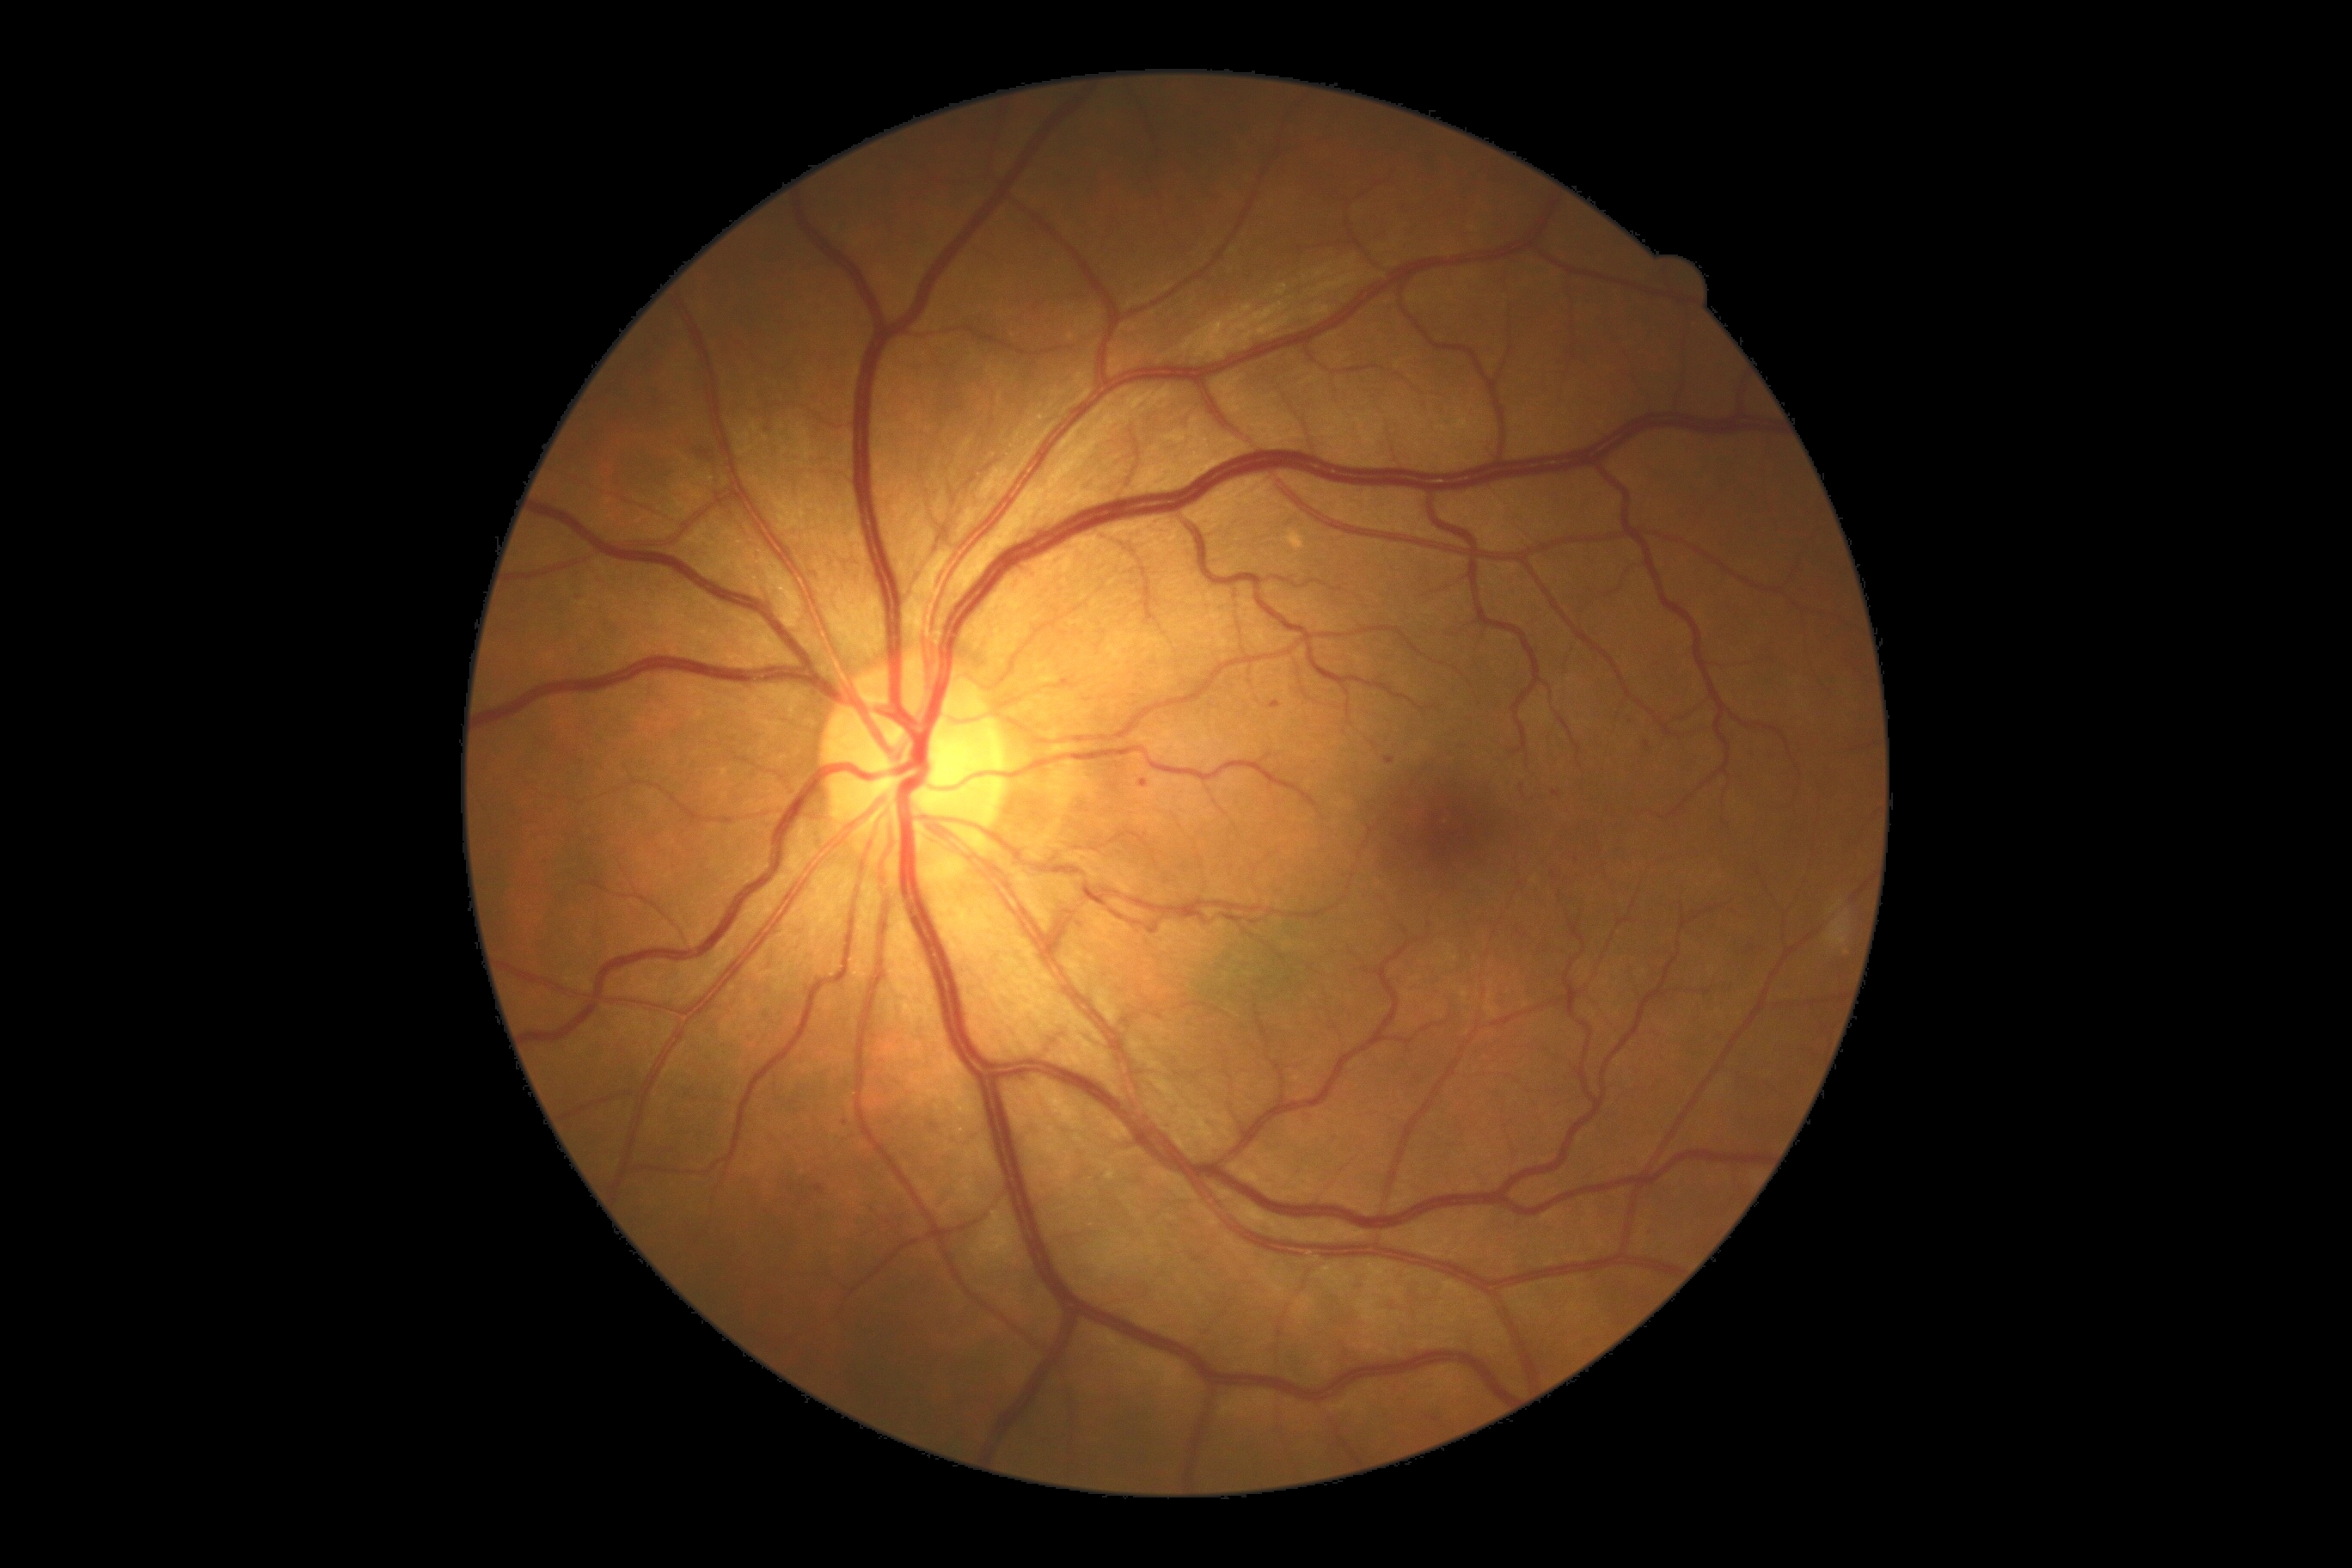 DR grade is 1
HEs: none
EXs: none
MAs: box=[816, 1184, 824, 1194] | box=[1270, 701, 1282, 709] | box=[1385, 757, 1395, 766] | box=[1139, 780, 1148, 788] | box=[1645, 742, 1650, 750]
Small MAs approximately at (1556,793) | (845,1123)
SEs: none